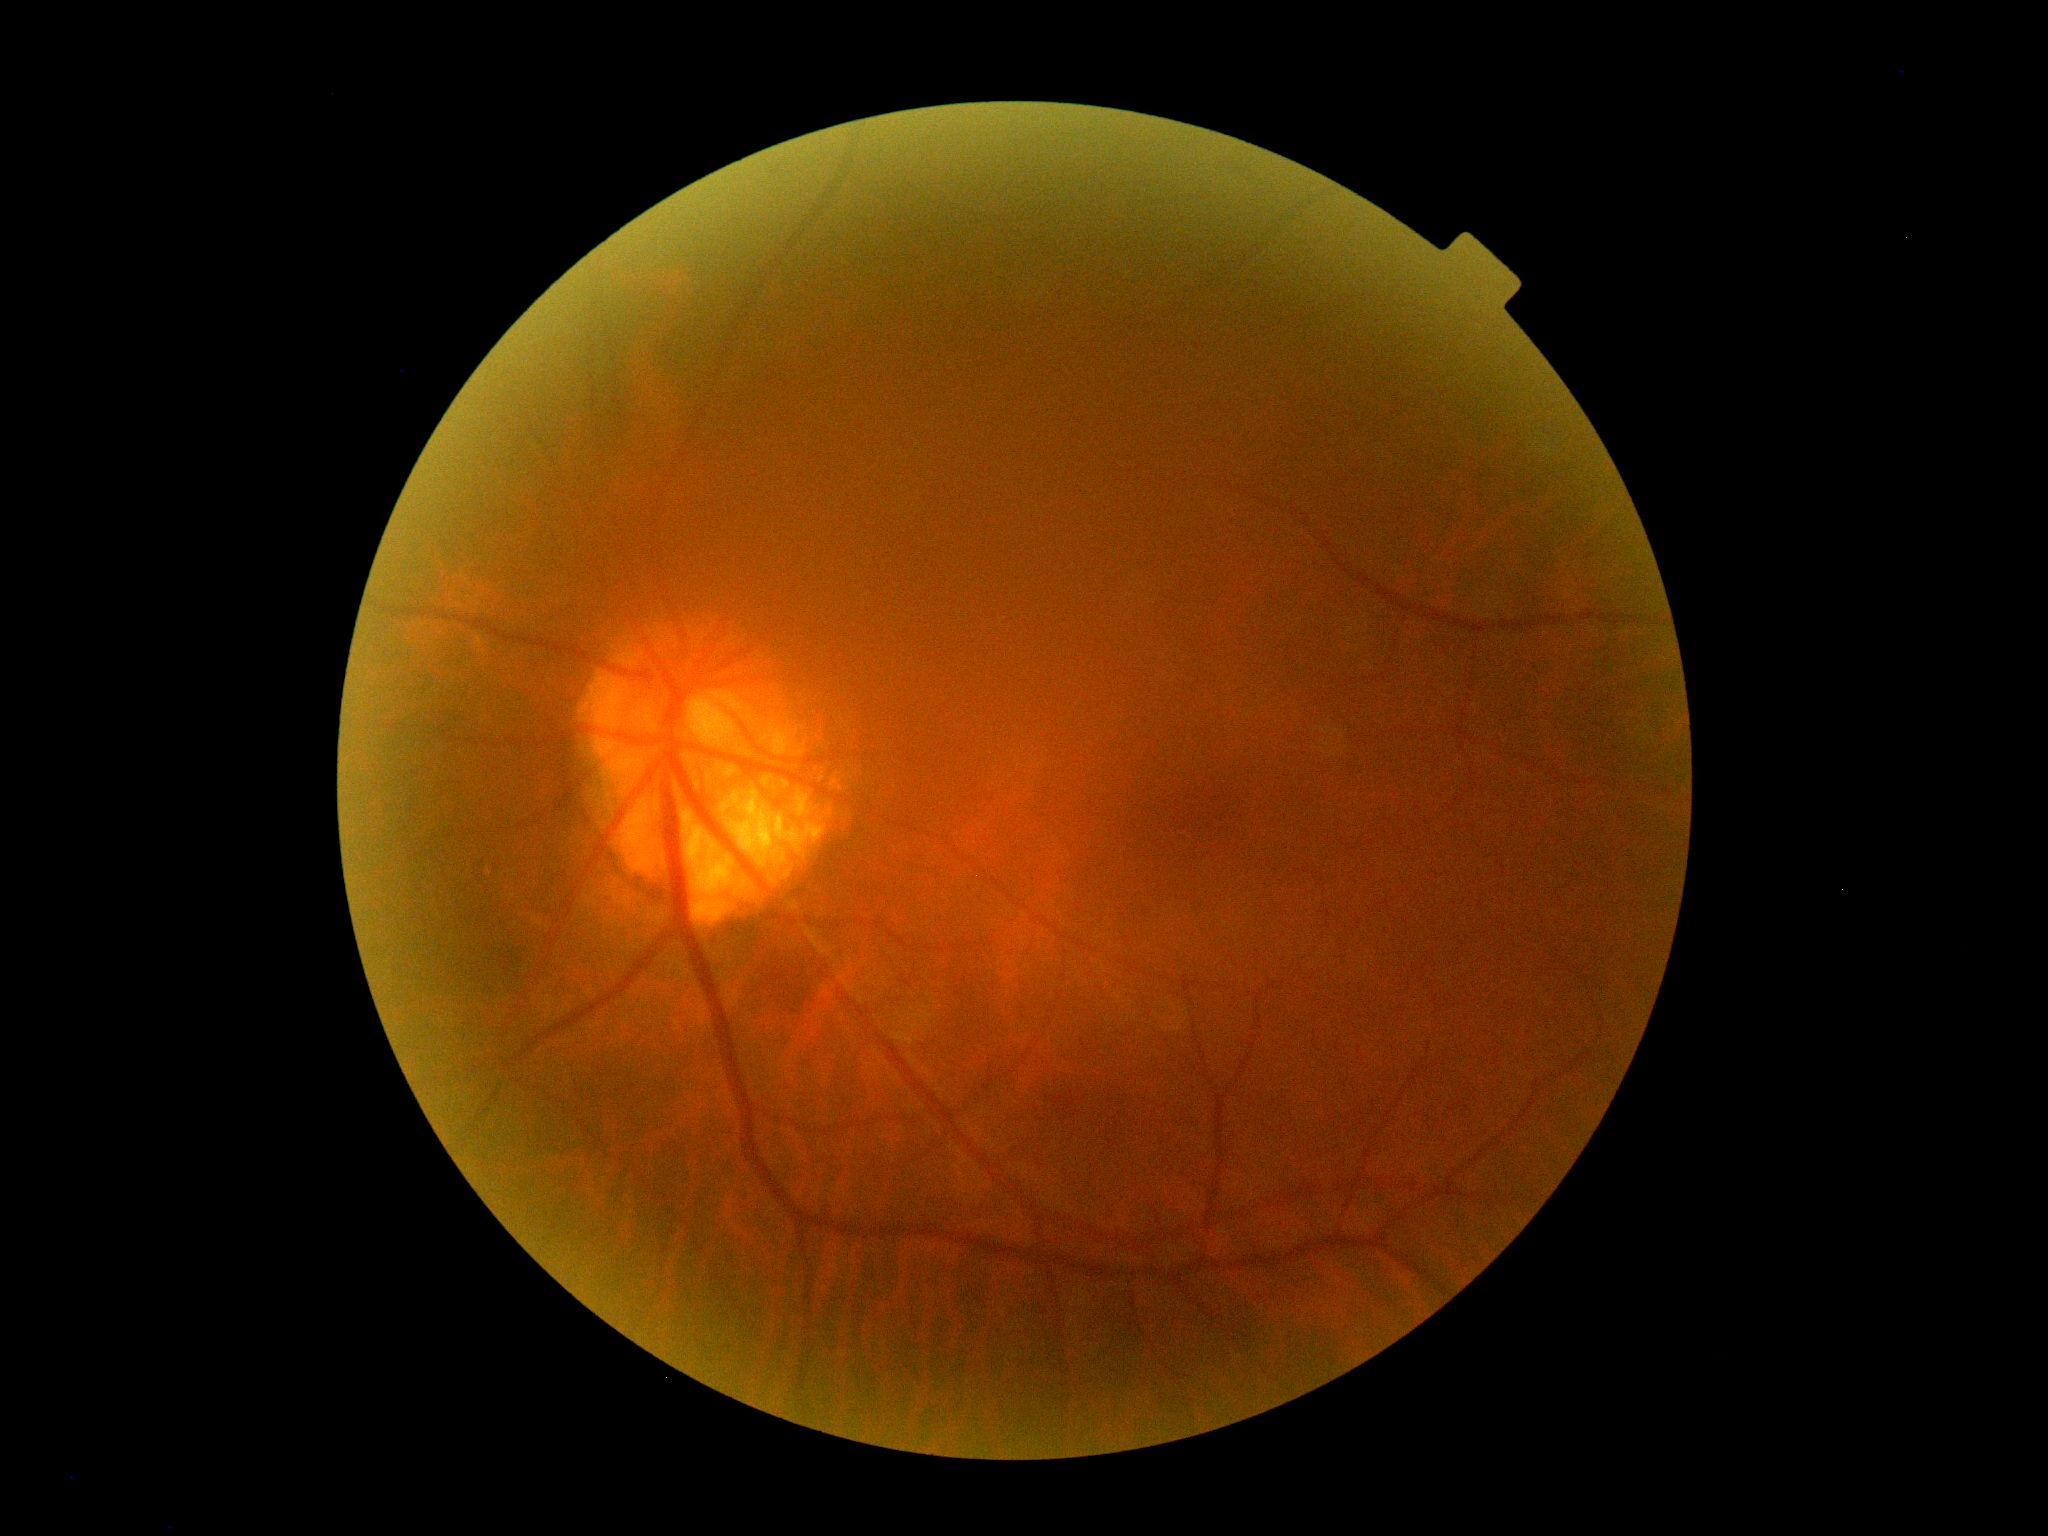 DR severity: no apparent diabetic retinopathy (grade 0).